Wide-field fundus photograph from neonatal ROP screening; 1440x1080px; Natus RetCam Envision, 130° FOV:
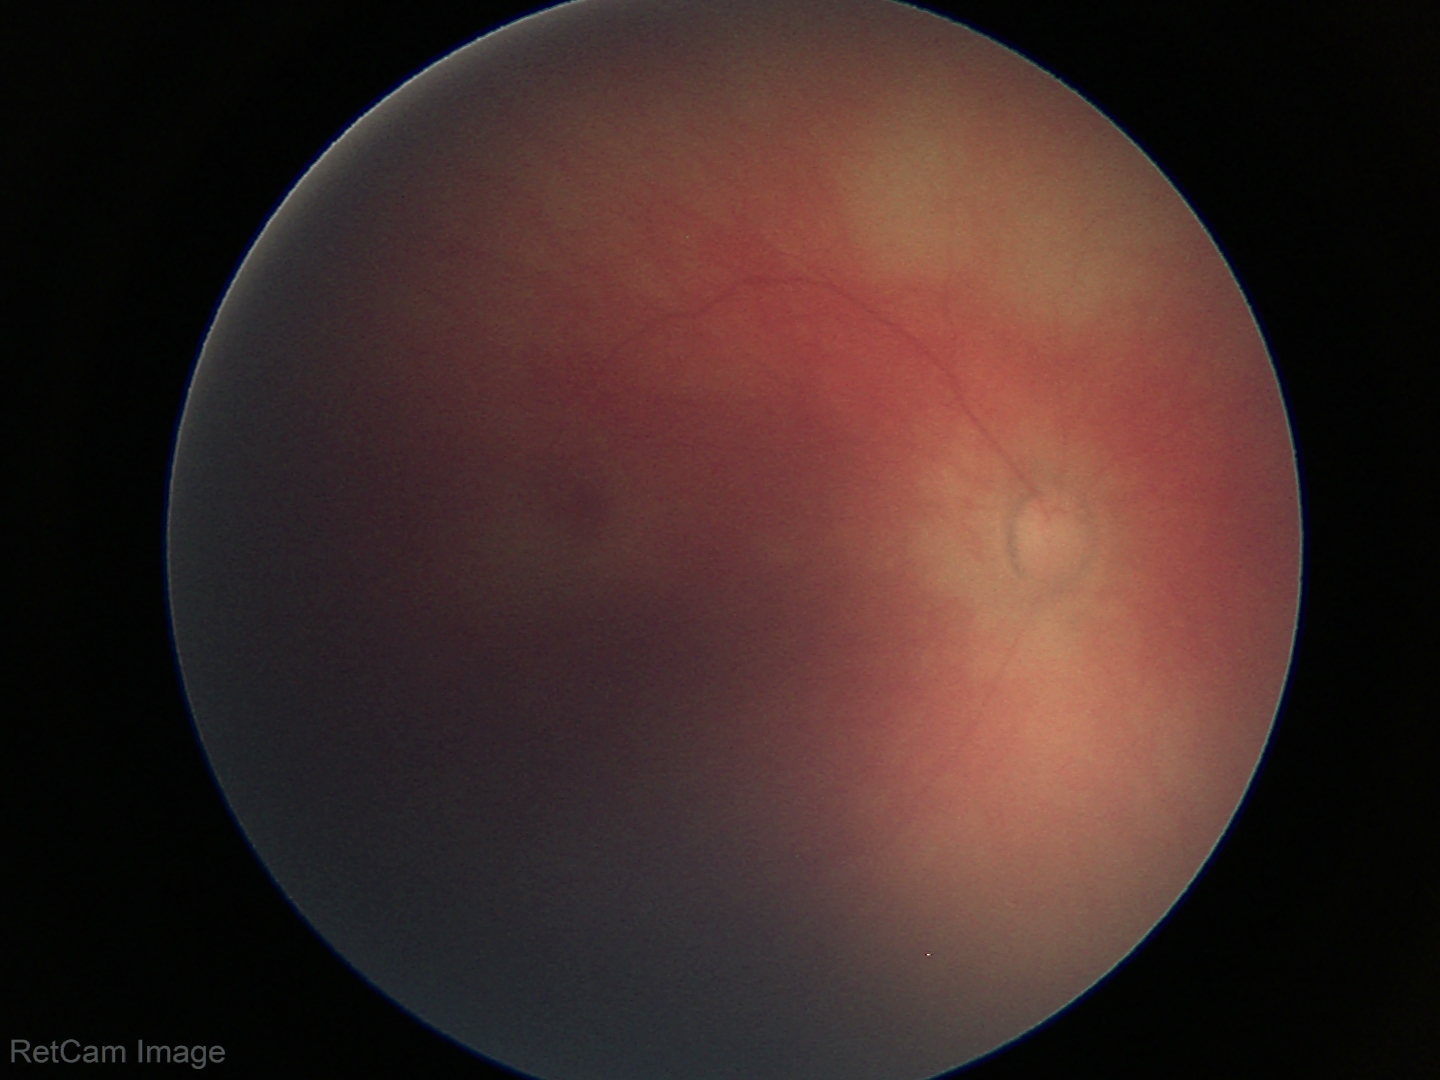
No retinal pathology identified on screening.